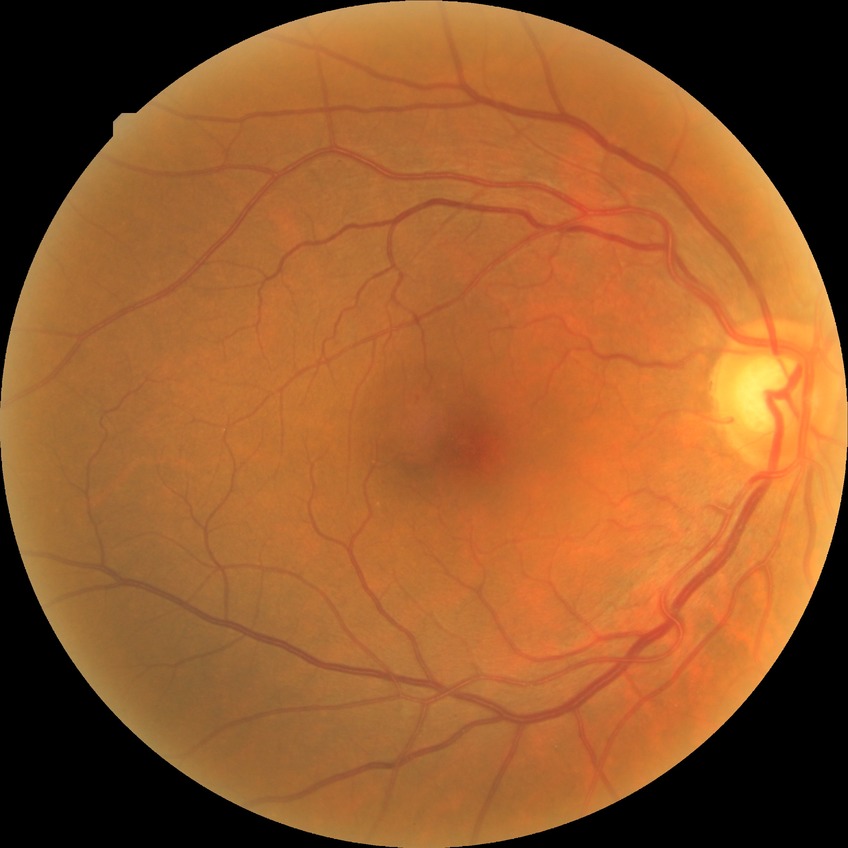

Diabetic retinopathy stage: simple diabetic retinopathy.